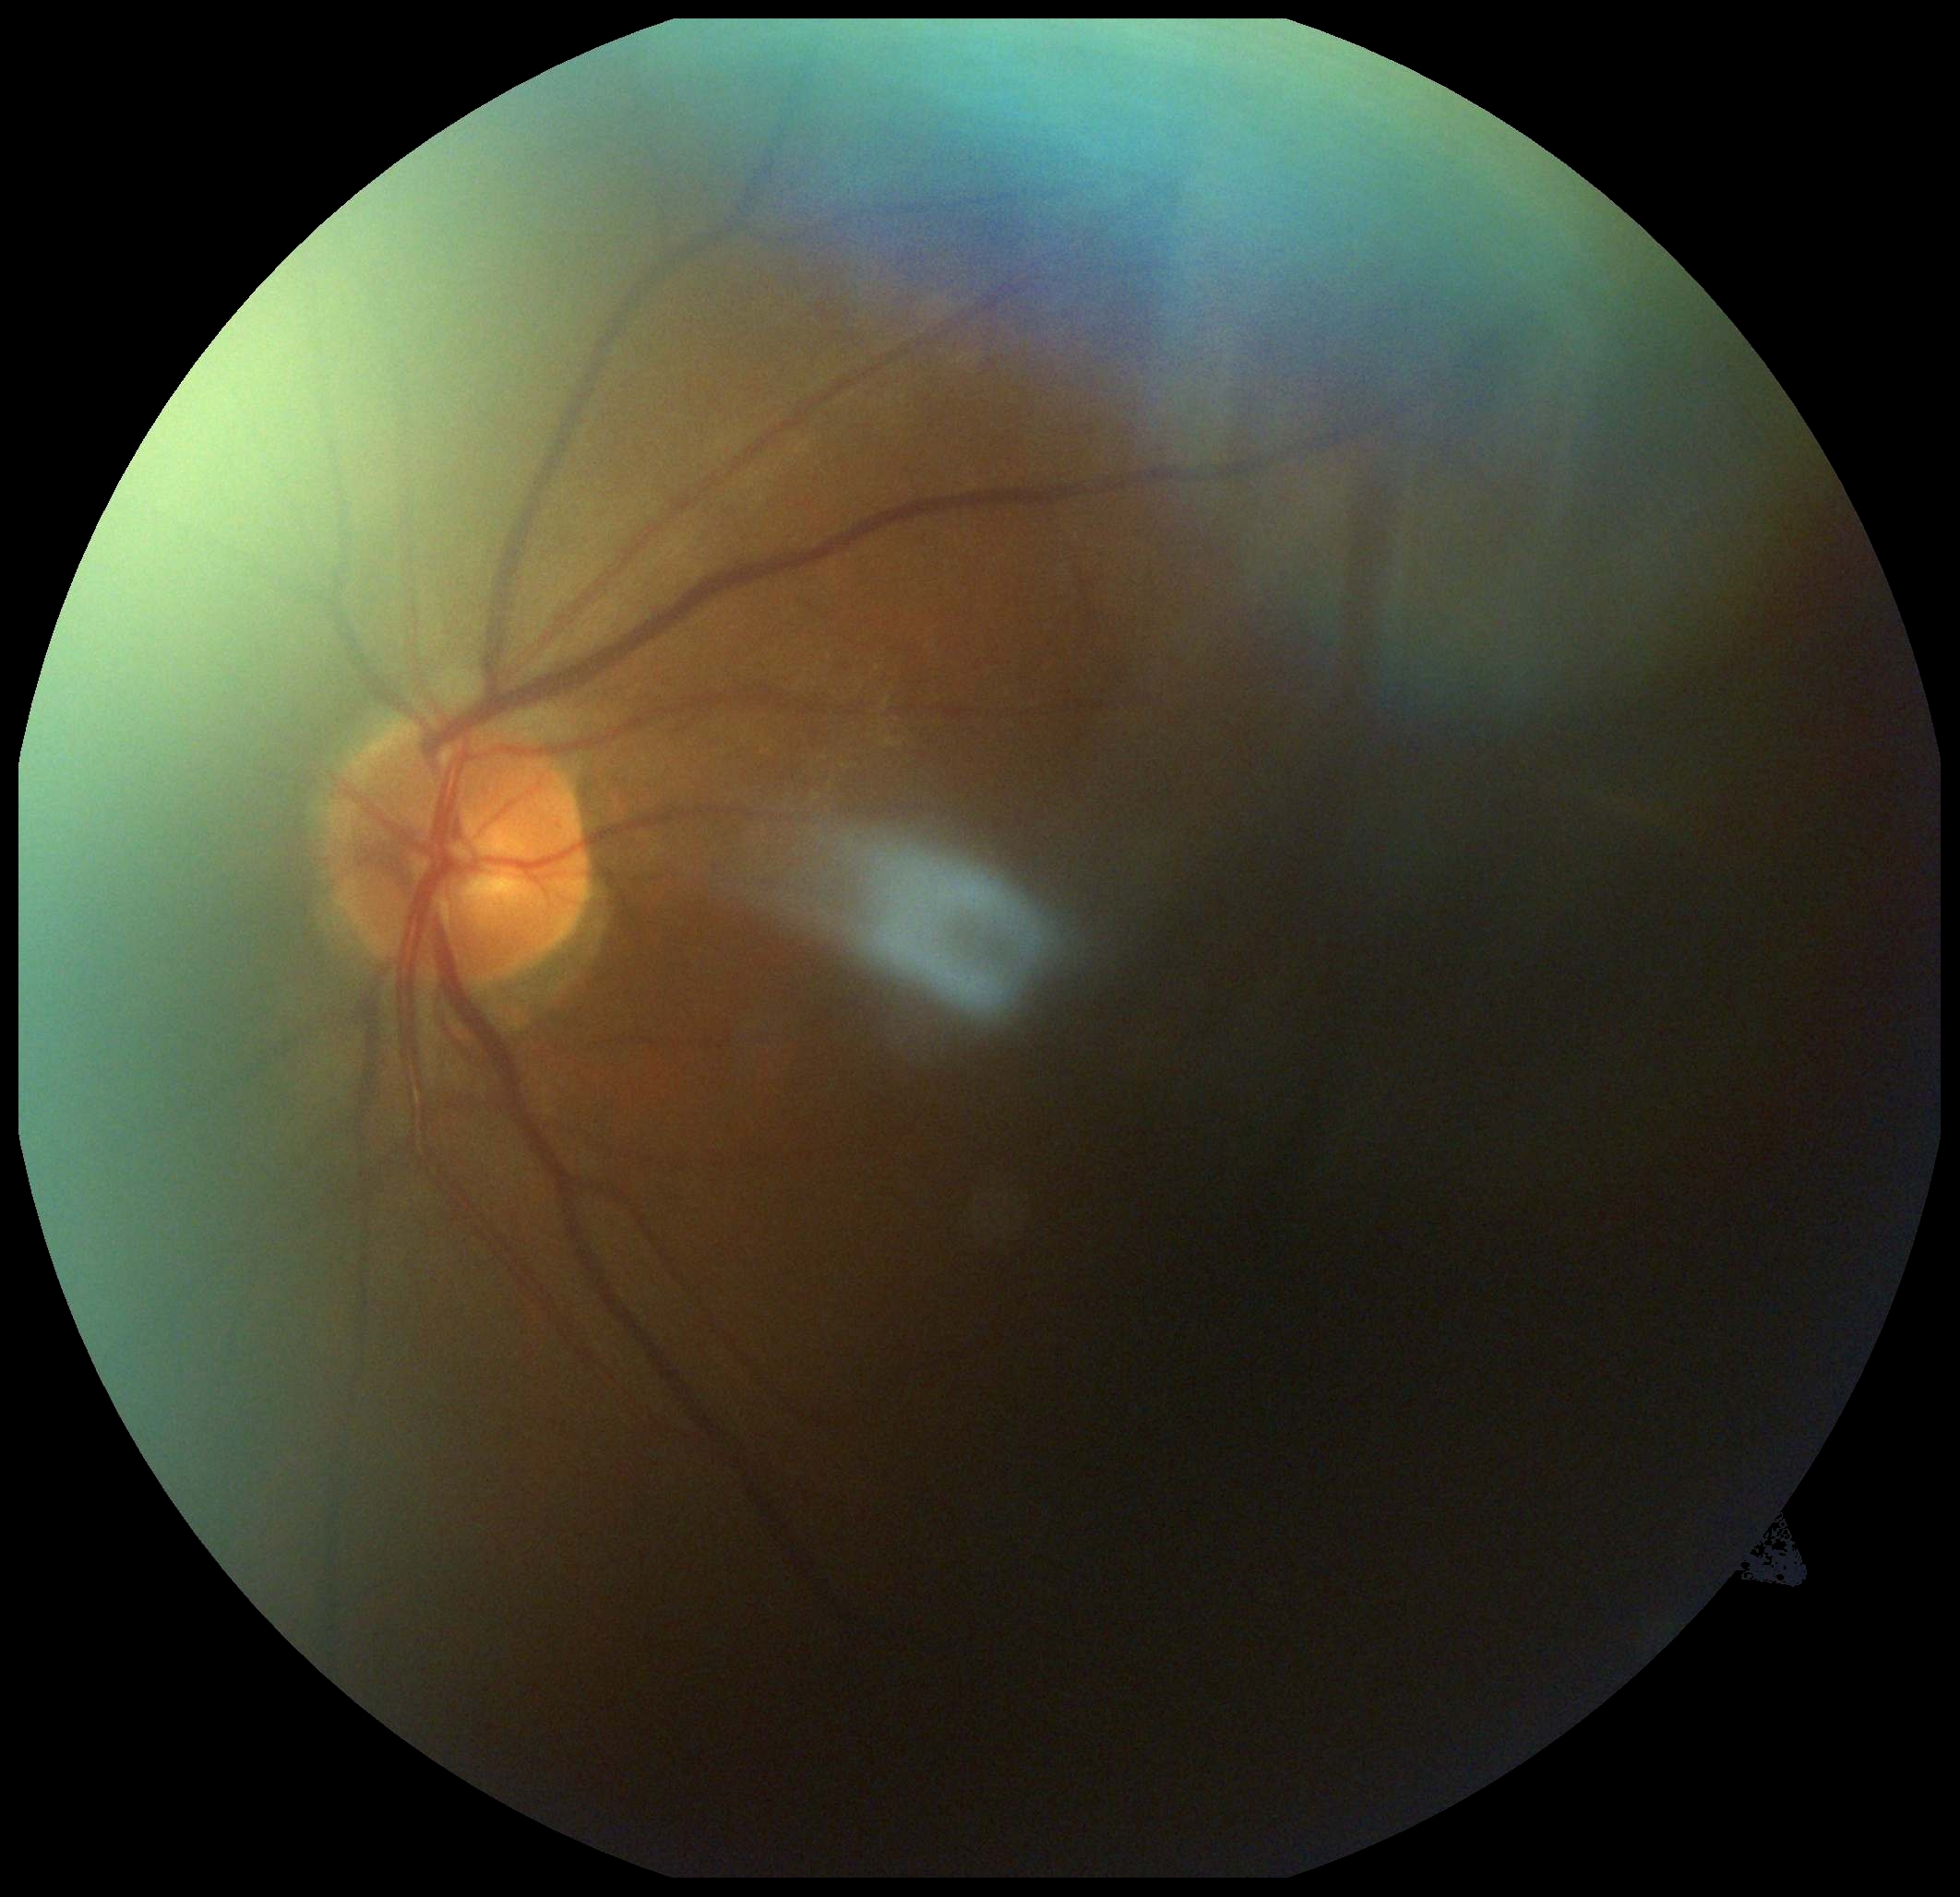

Diabetic retinopathy (DR): ungradable. Ungradable image — DR severity cannot be determined.